NIDEK AFC-230. Posterior pole photograph. 848 by 848 pixels. Without pupil dilation. 45-degree field of view. Davis DR grading.
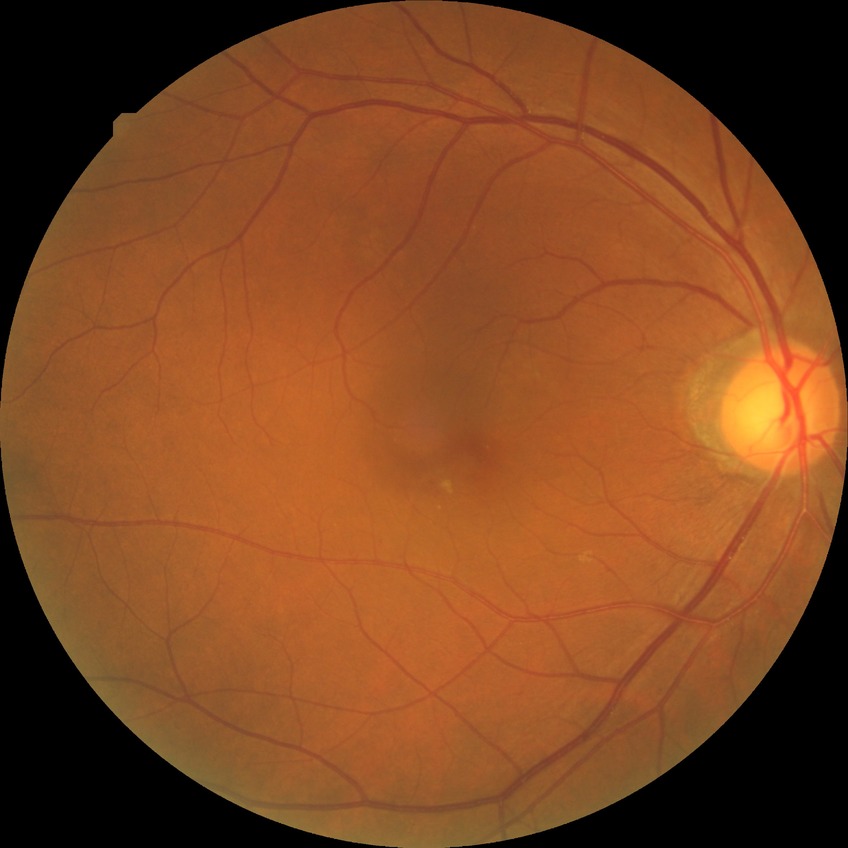
DR stage is NDR.